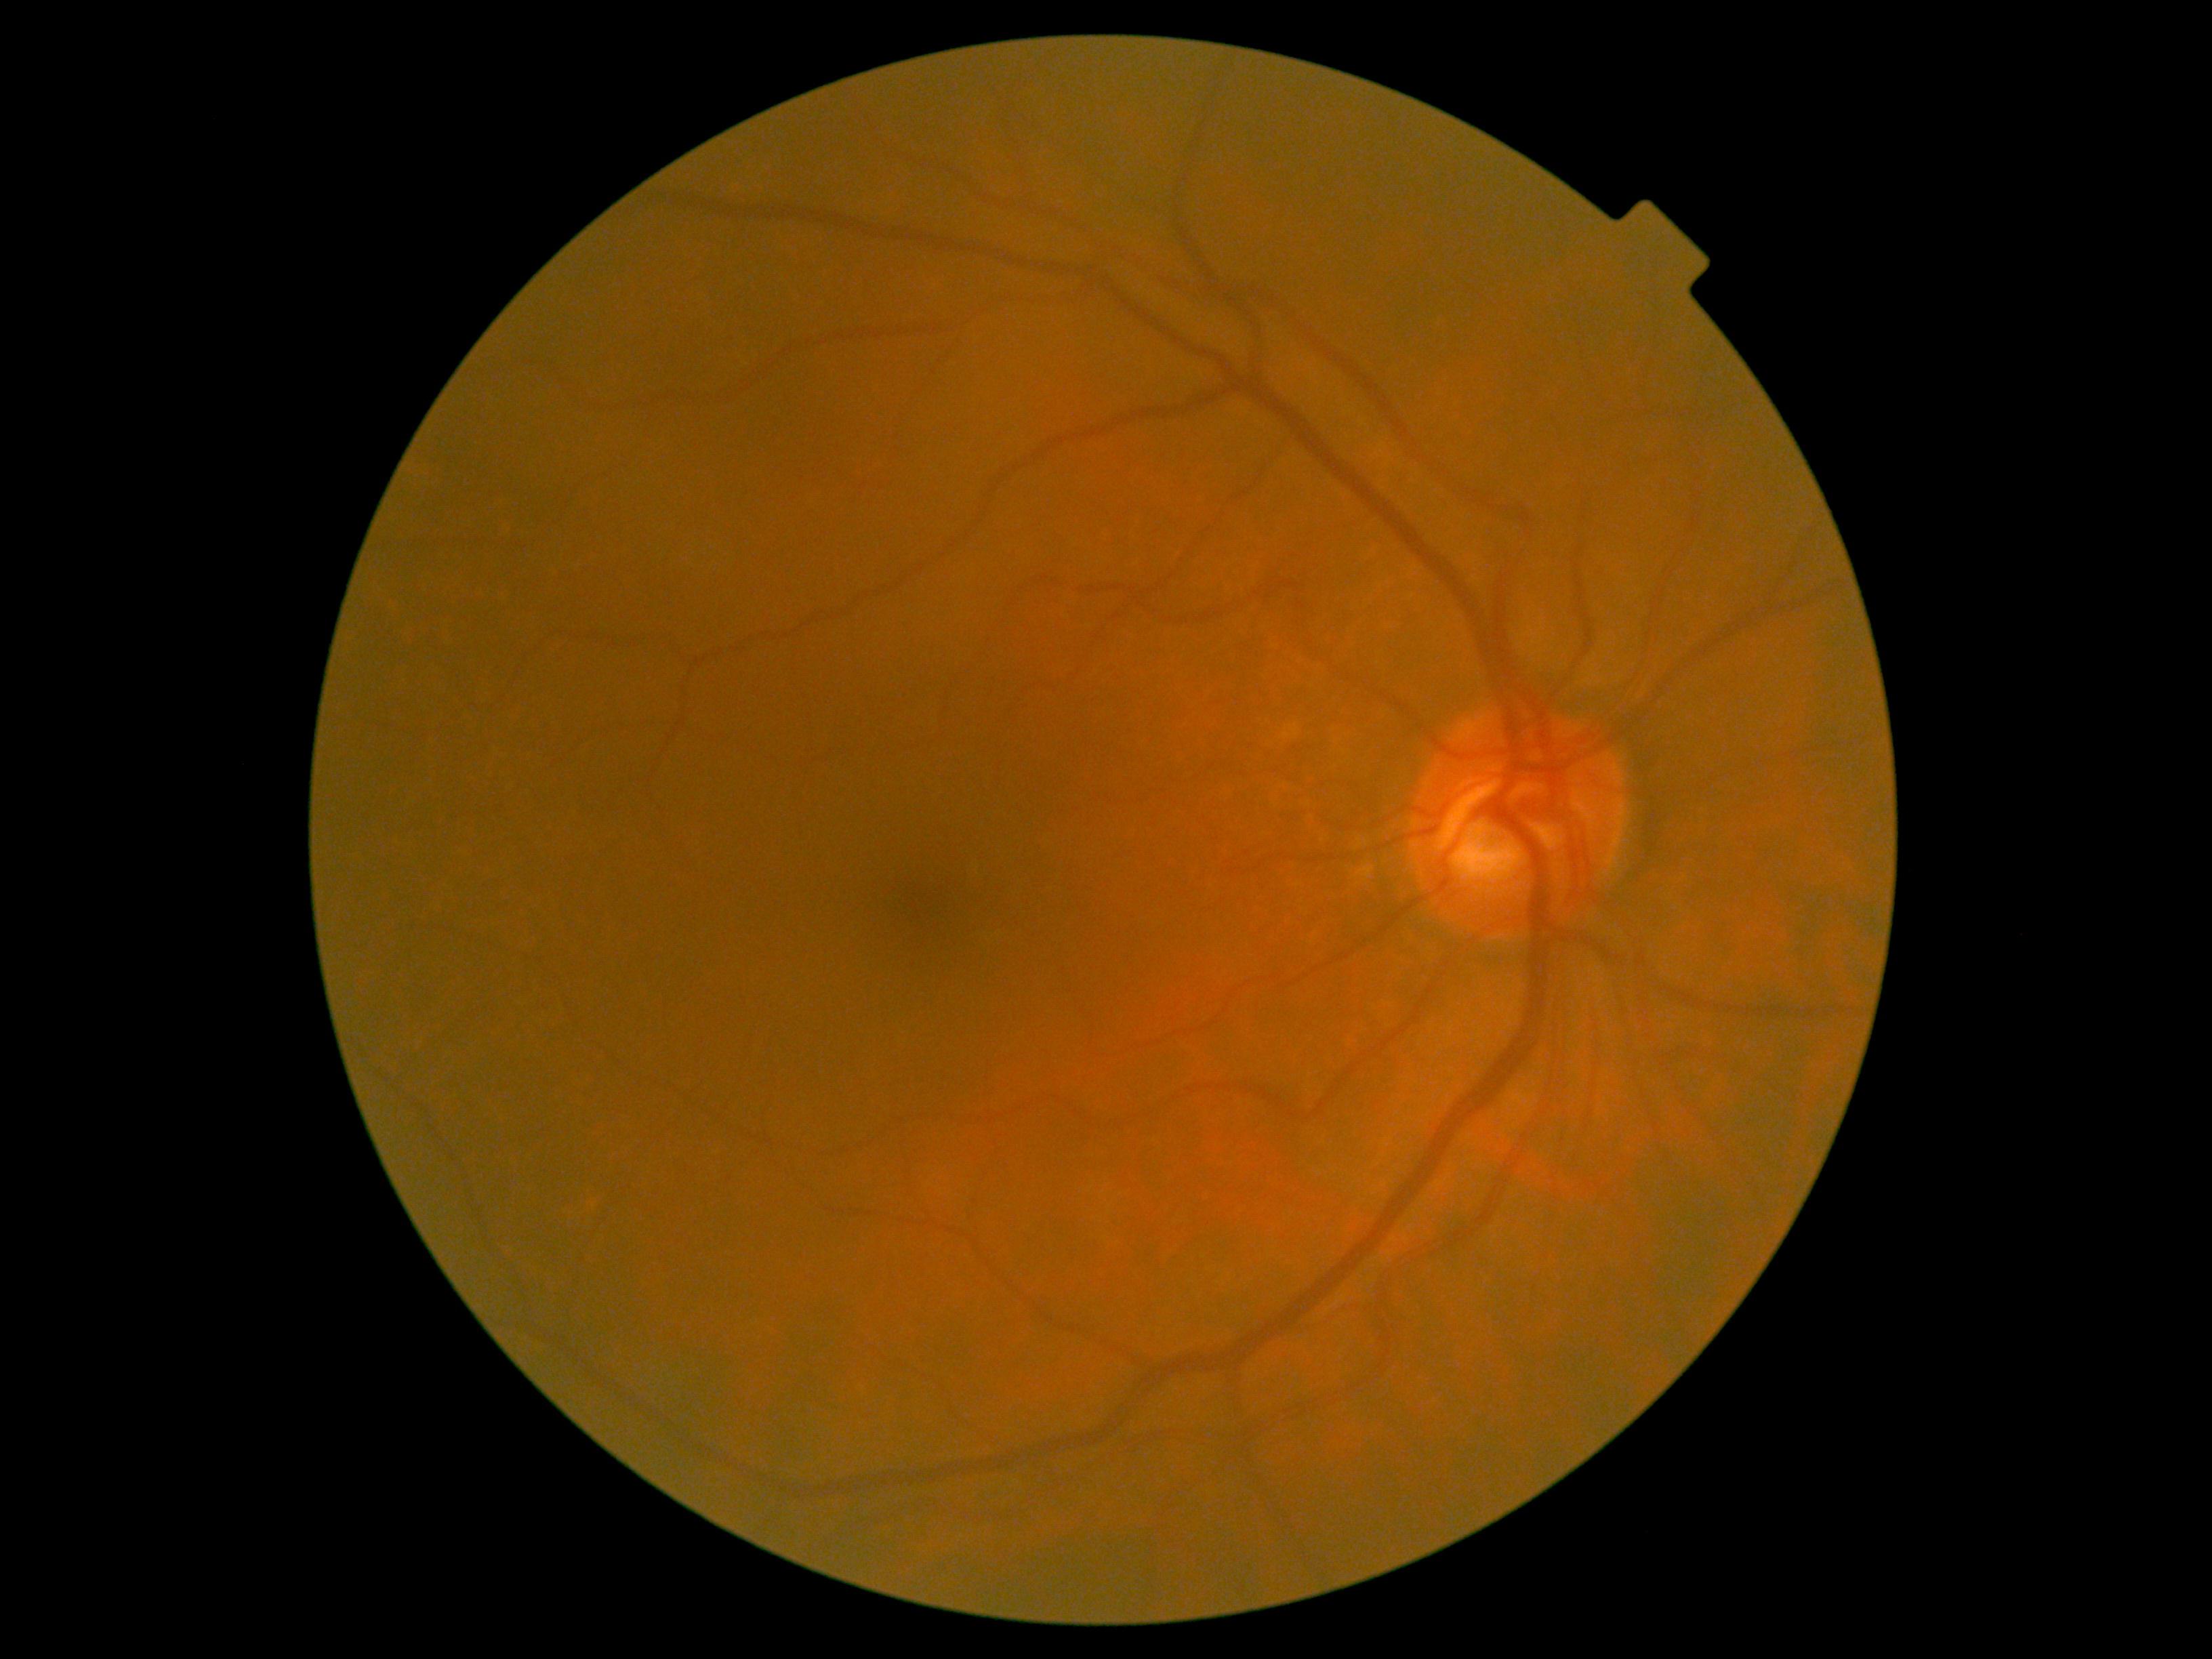

DR=no apparent retinopathy (grade 0).